Color fundus photograph: 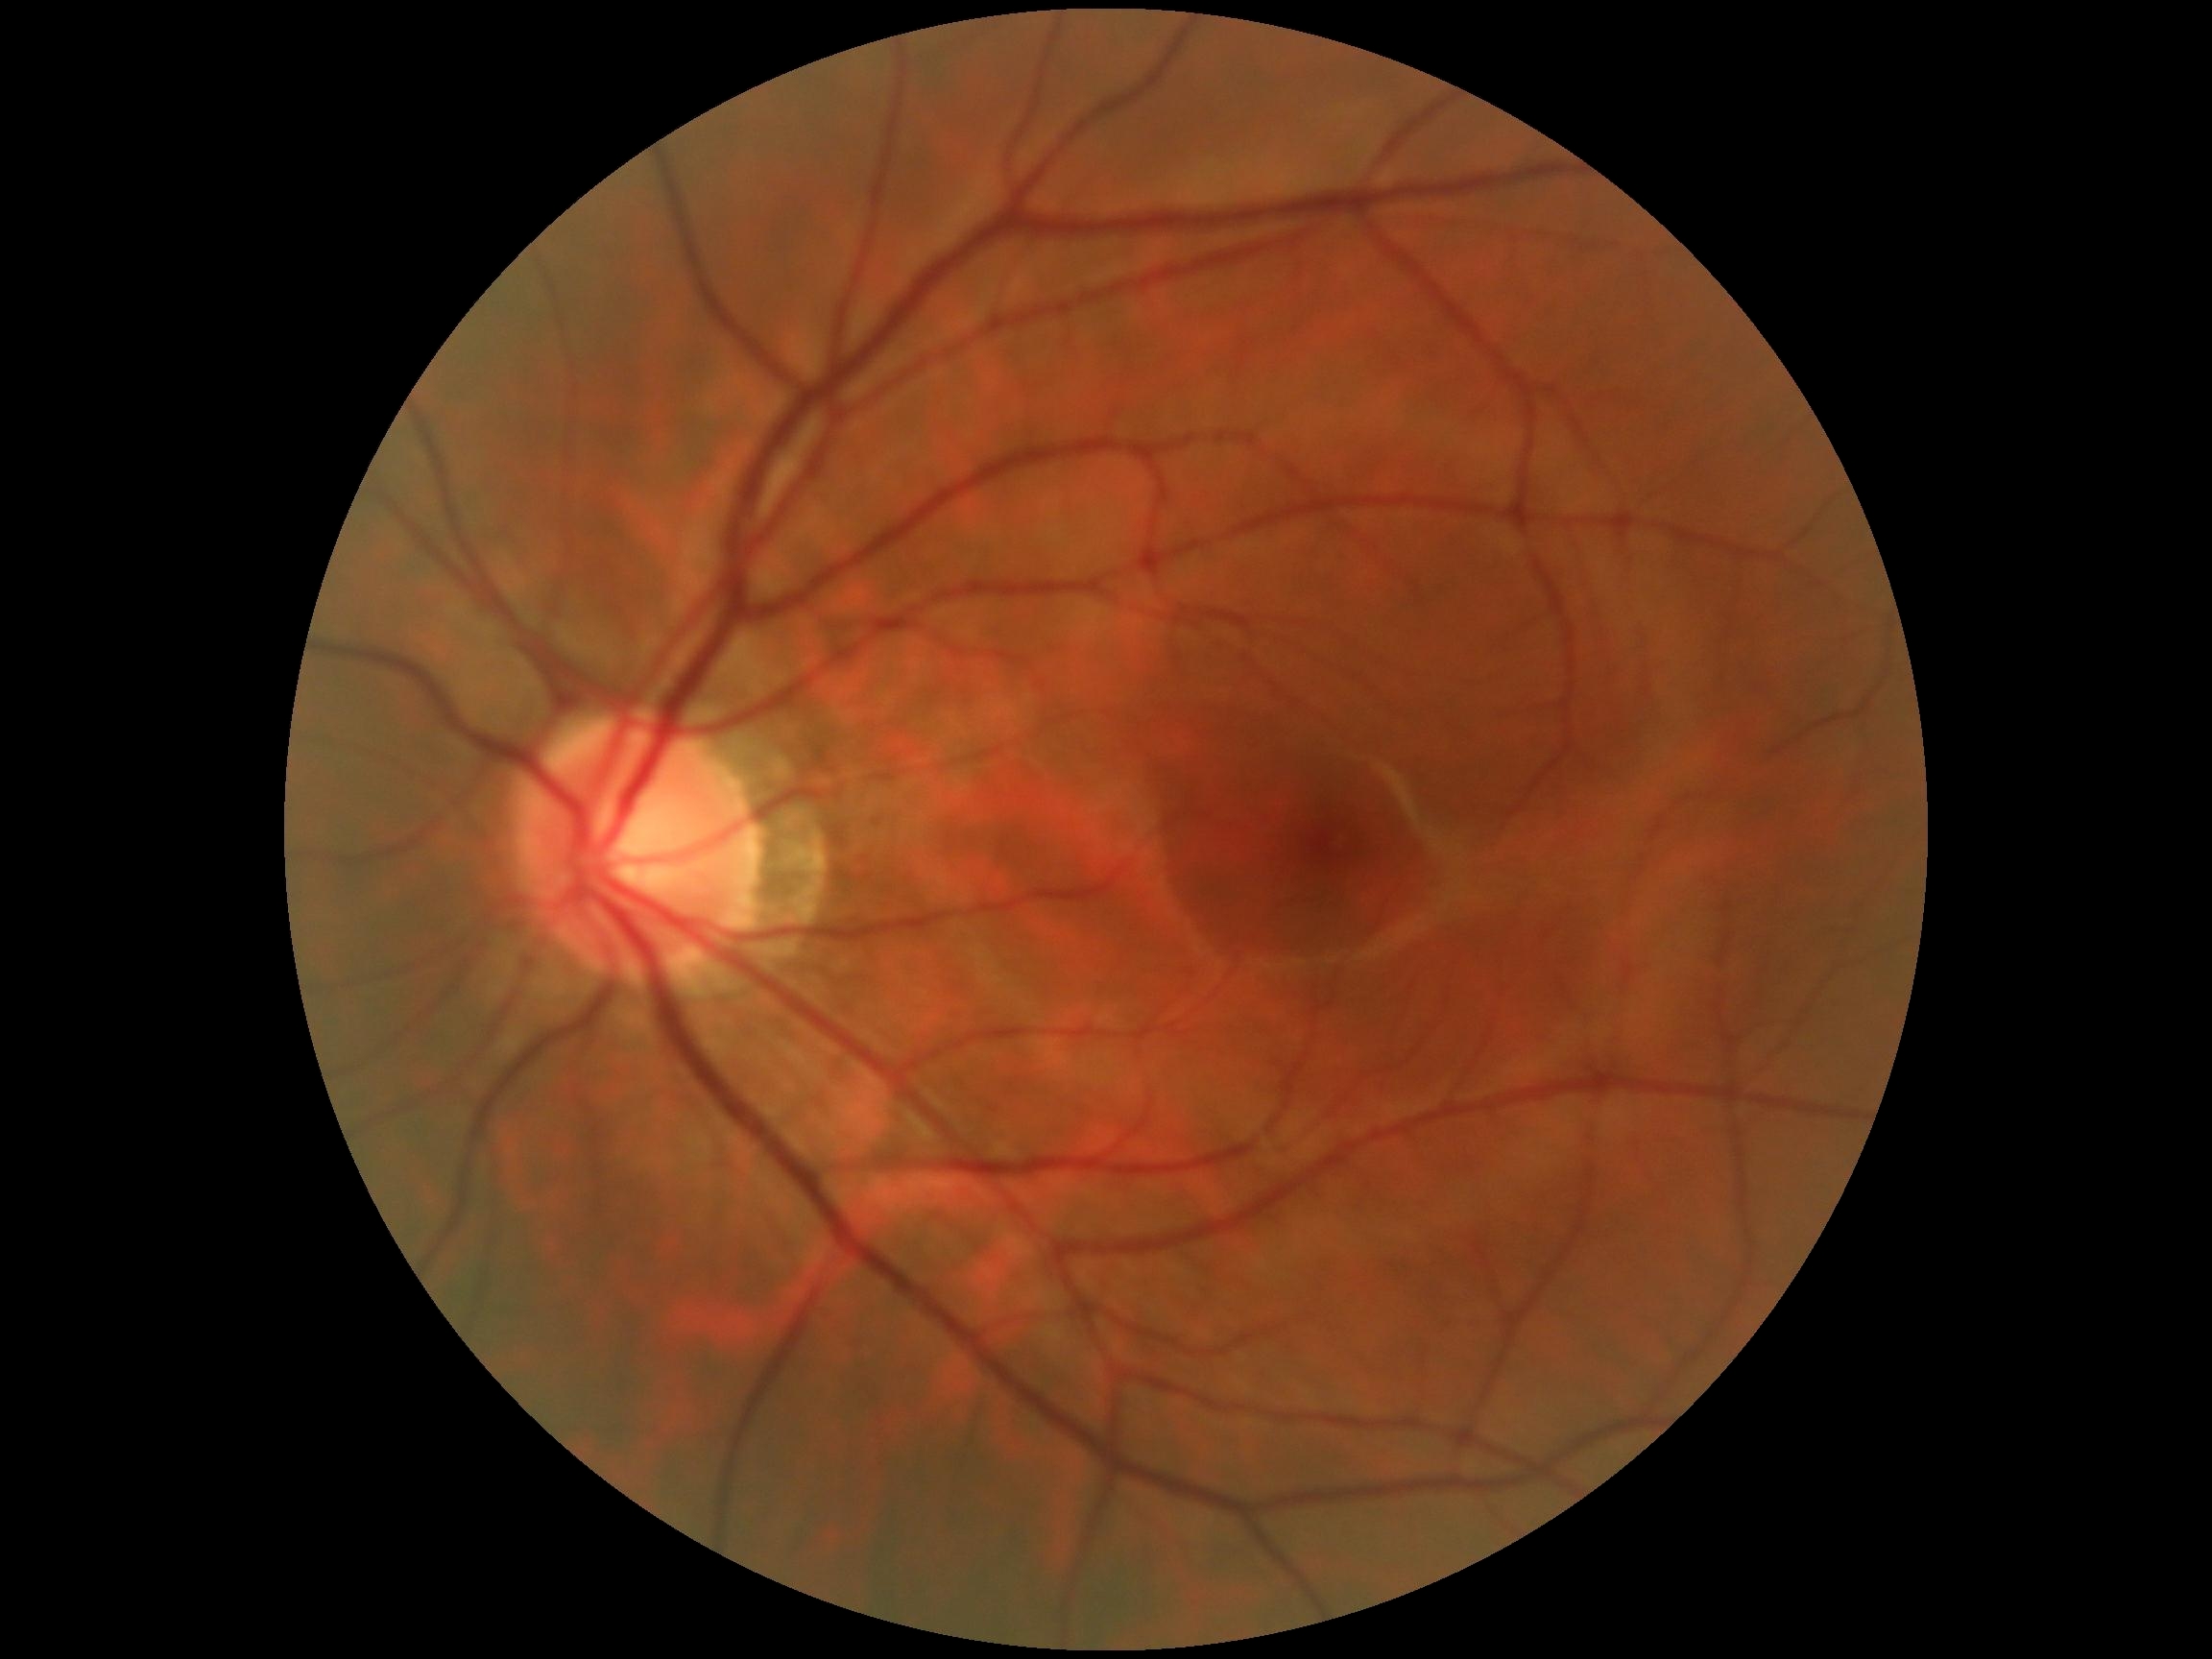

Diabetic retinopathy (DR) is no apparent diabetic retinopathy (grade 0).